FOV: 45 degrees; 848 by 848 pixels; modified Davis grading; camera: NIDEK AFC-230: 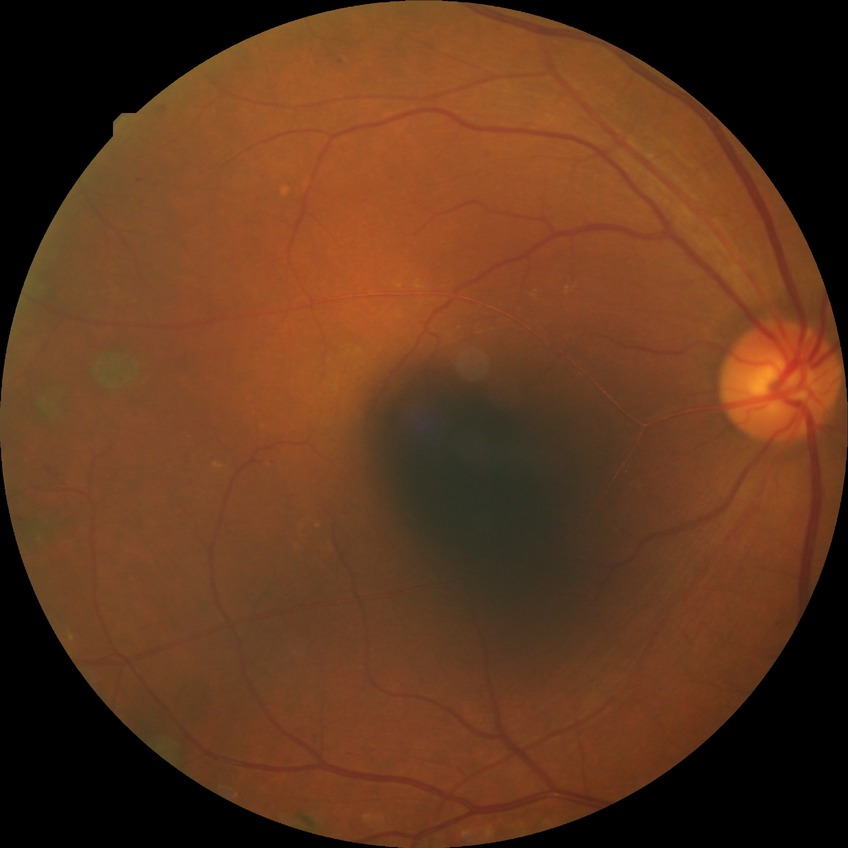 Diabetic retinopathy severity is proliferative diabetic retinopathy.